Wide-field fundus photograph of an infant
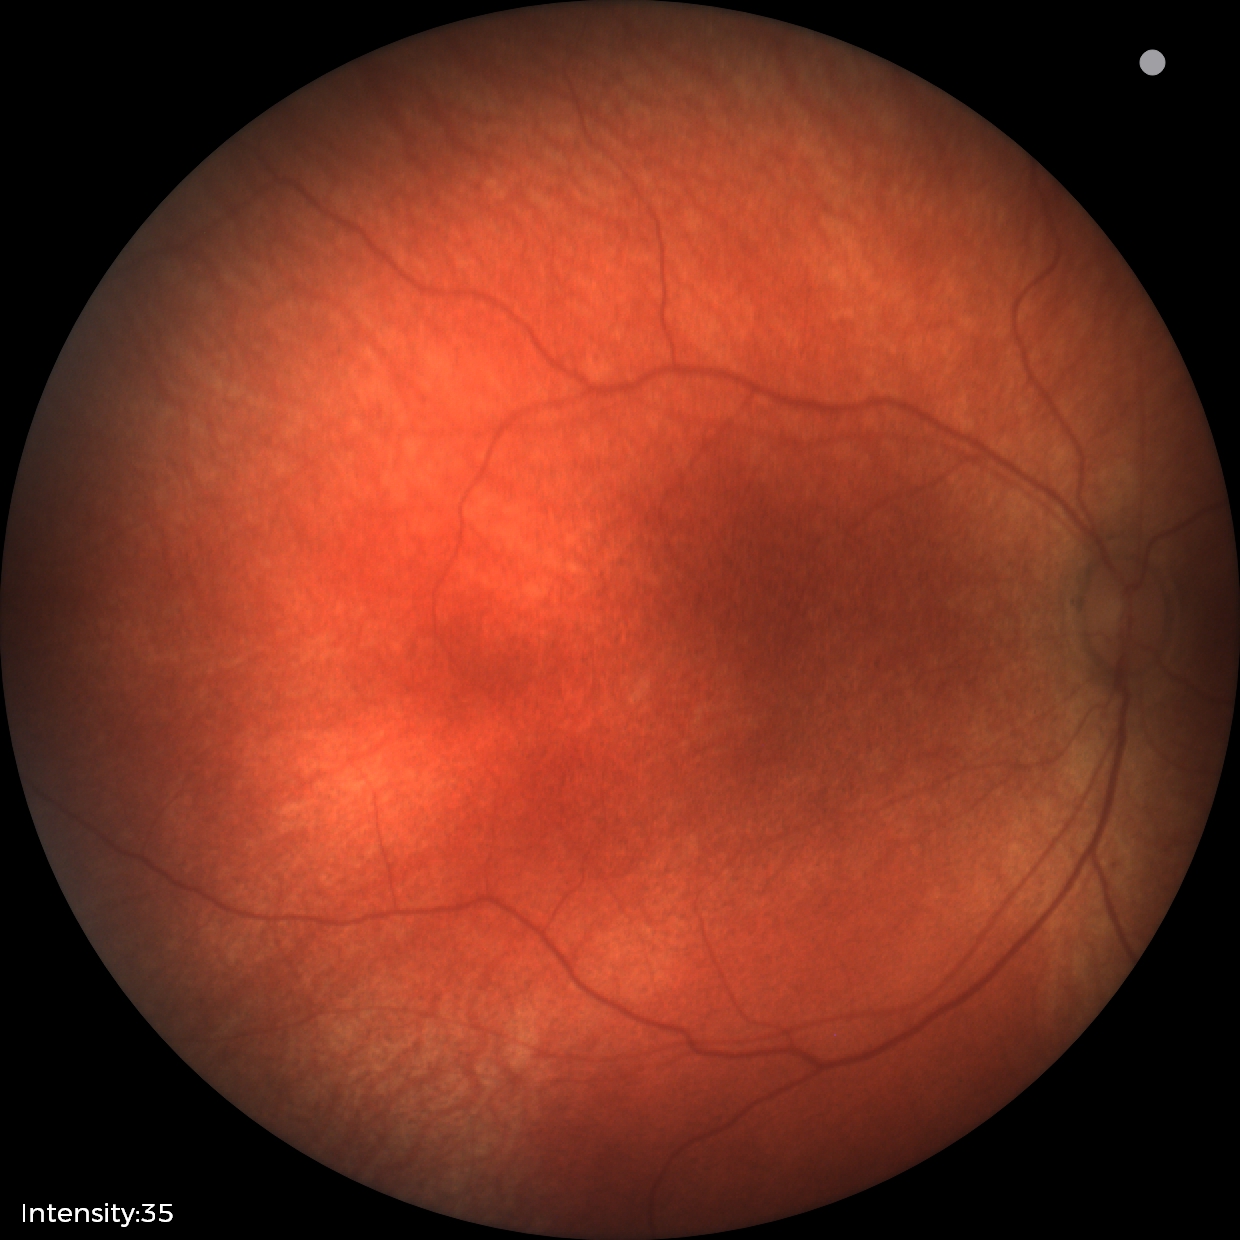 Impression = normal.